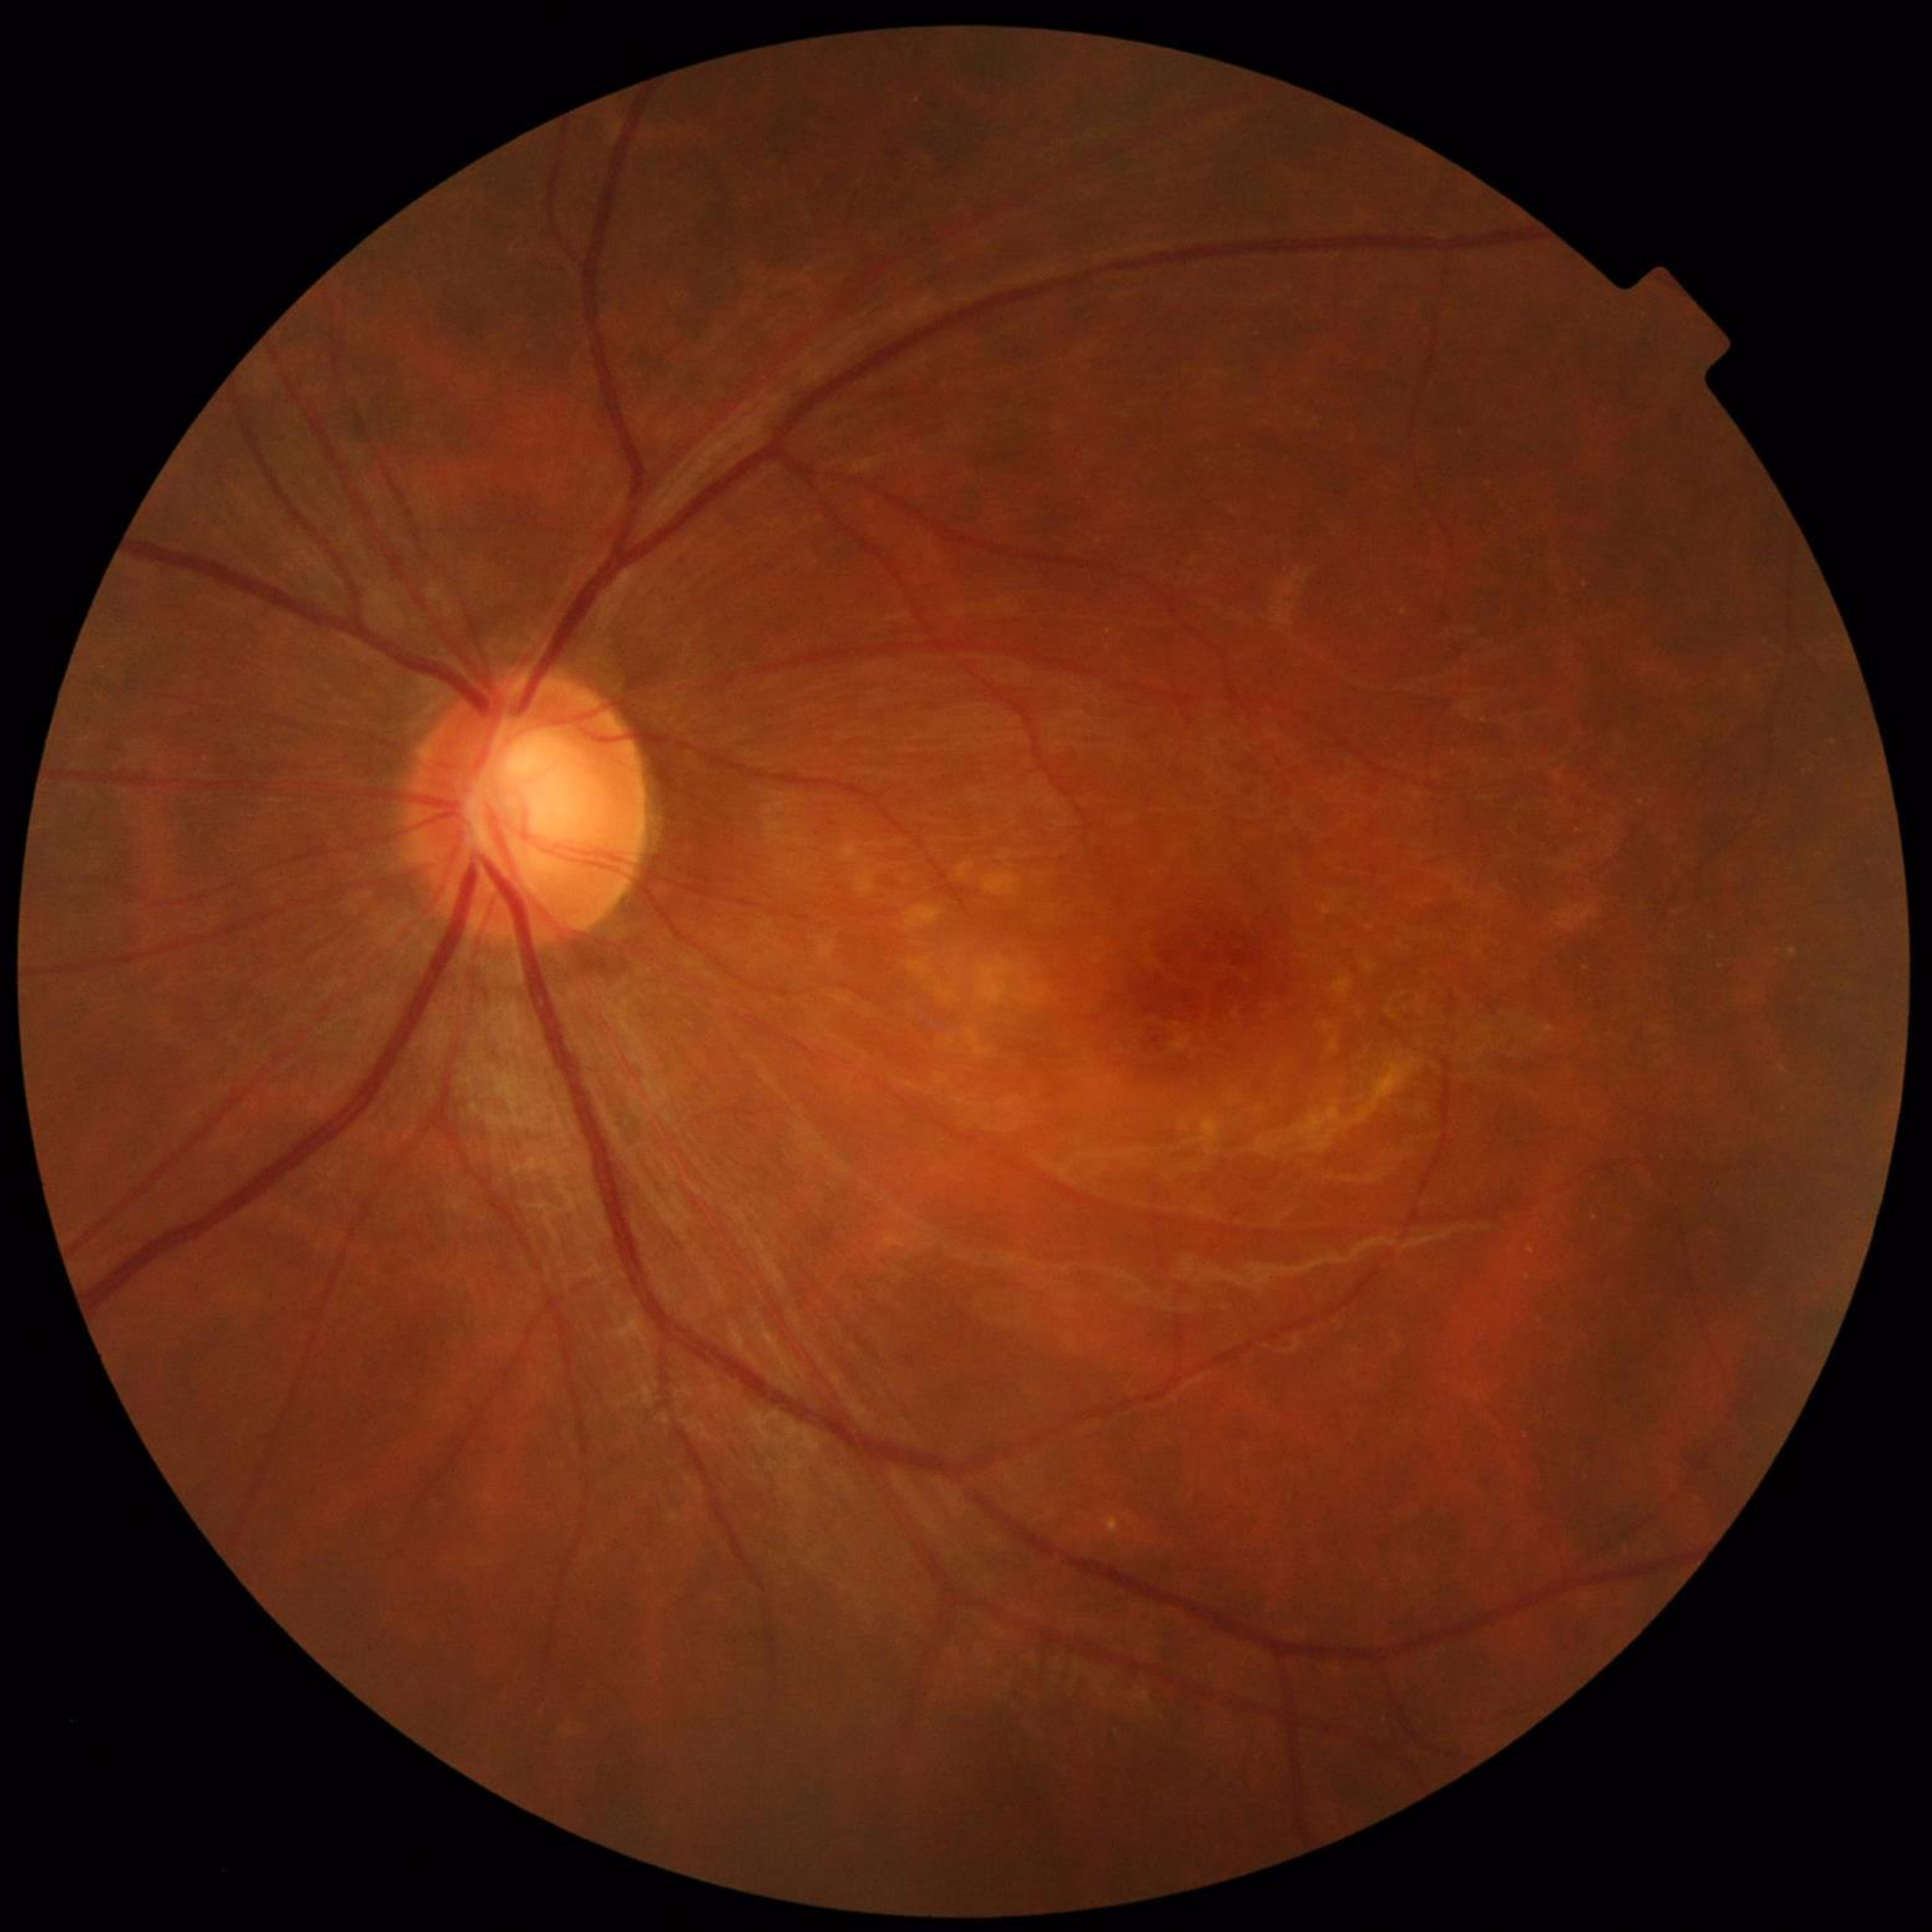 Diagnosed with age-related macular degeneration.